Camera: NIDEK AFC-230 — 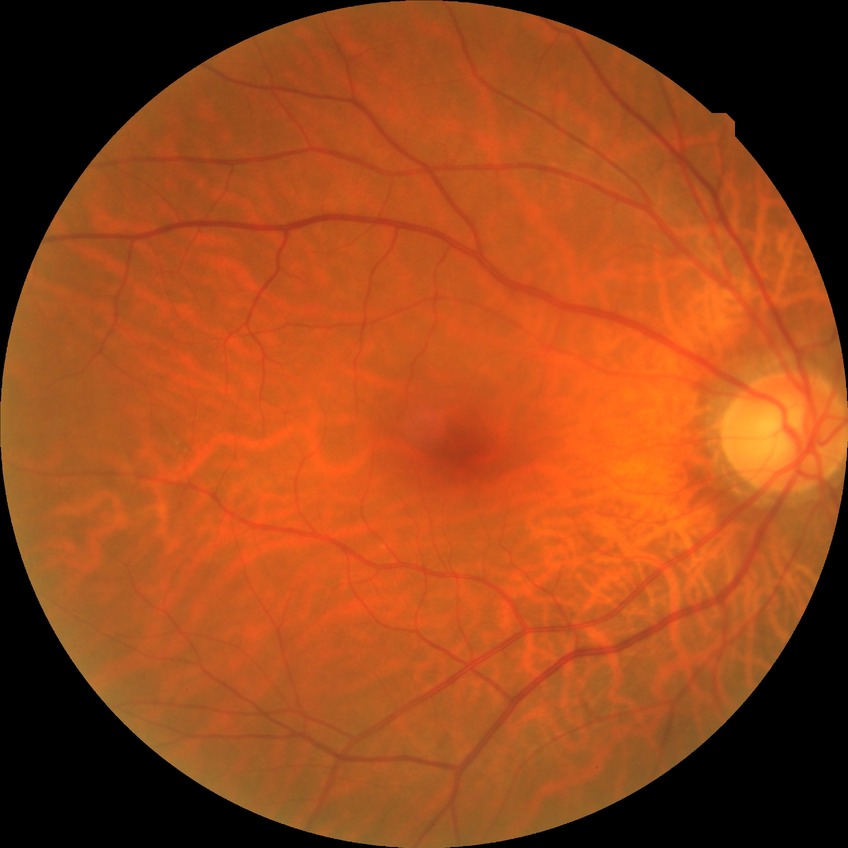
Retinopathy stage is no diabetic retinopathy.